CFP · 45-degree field of view
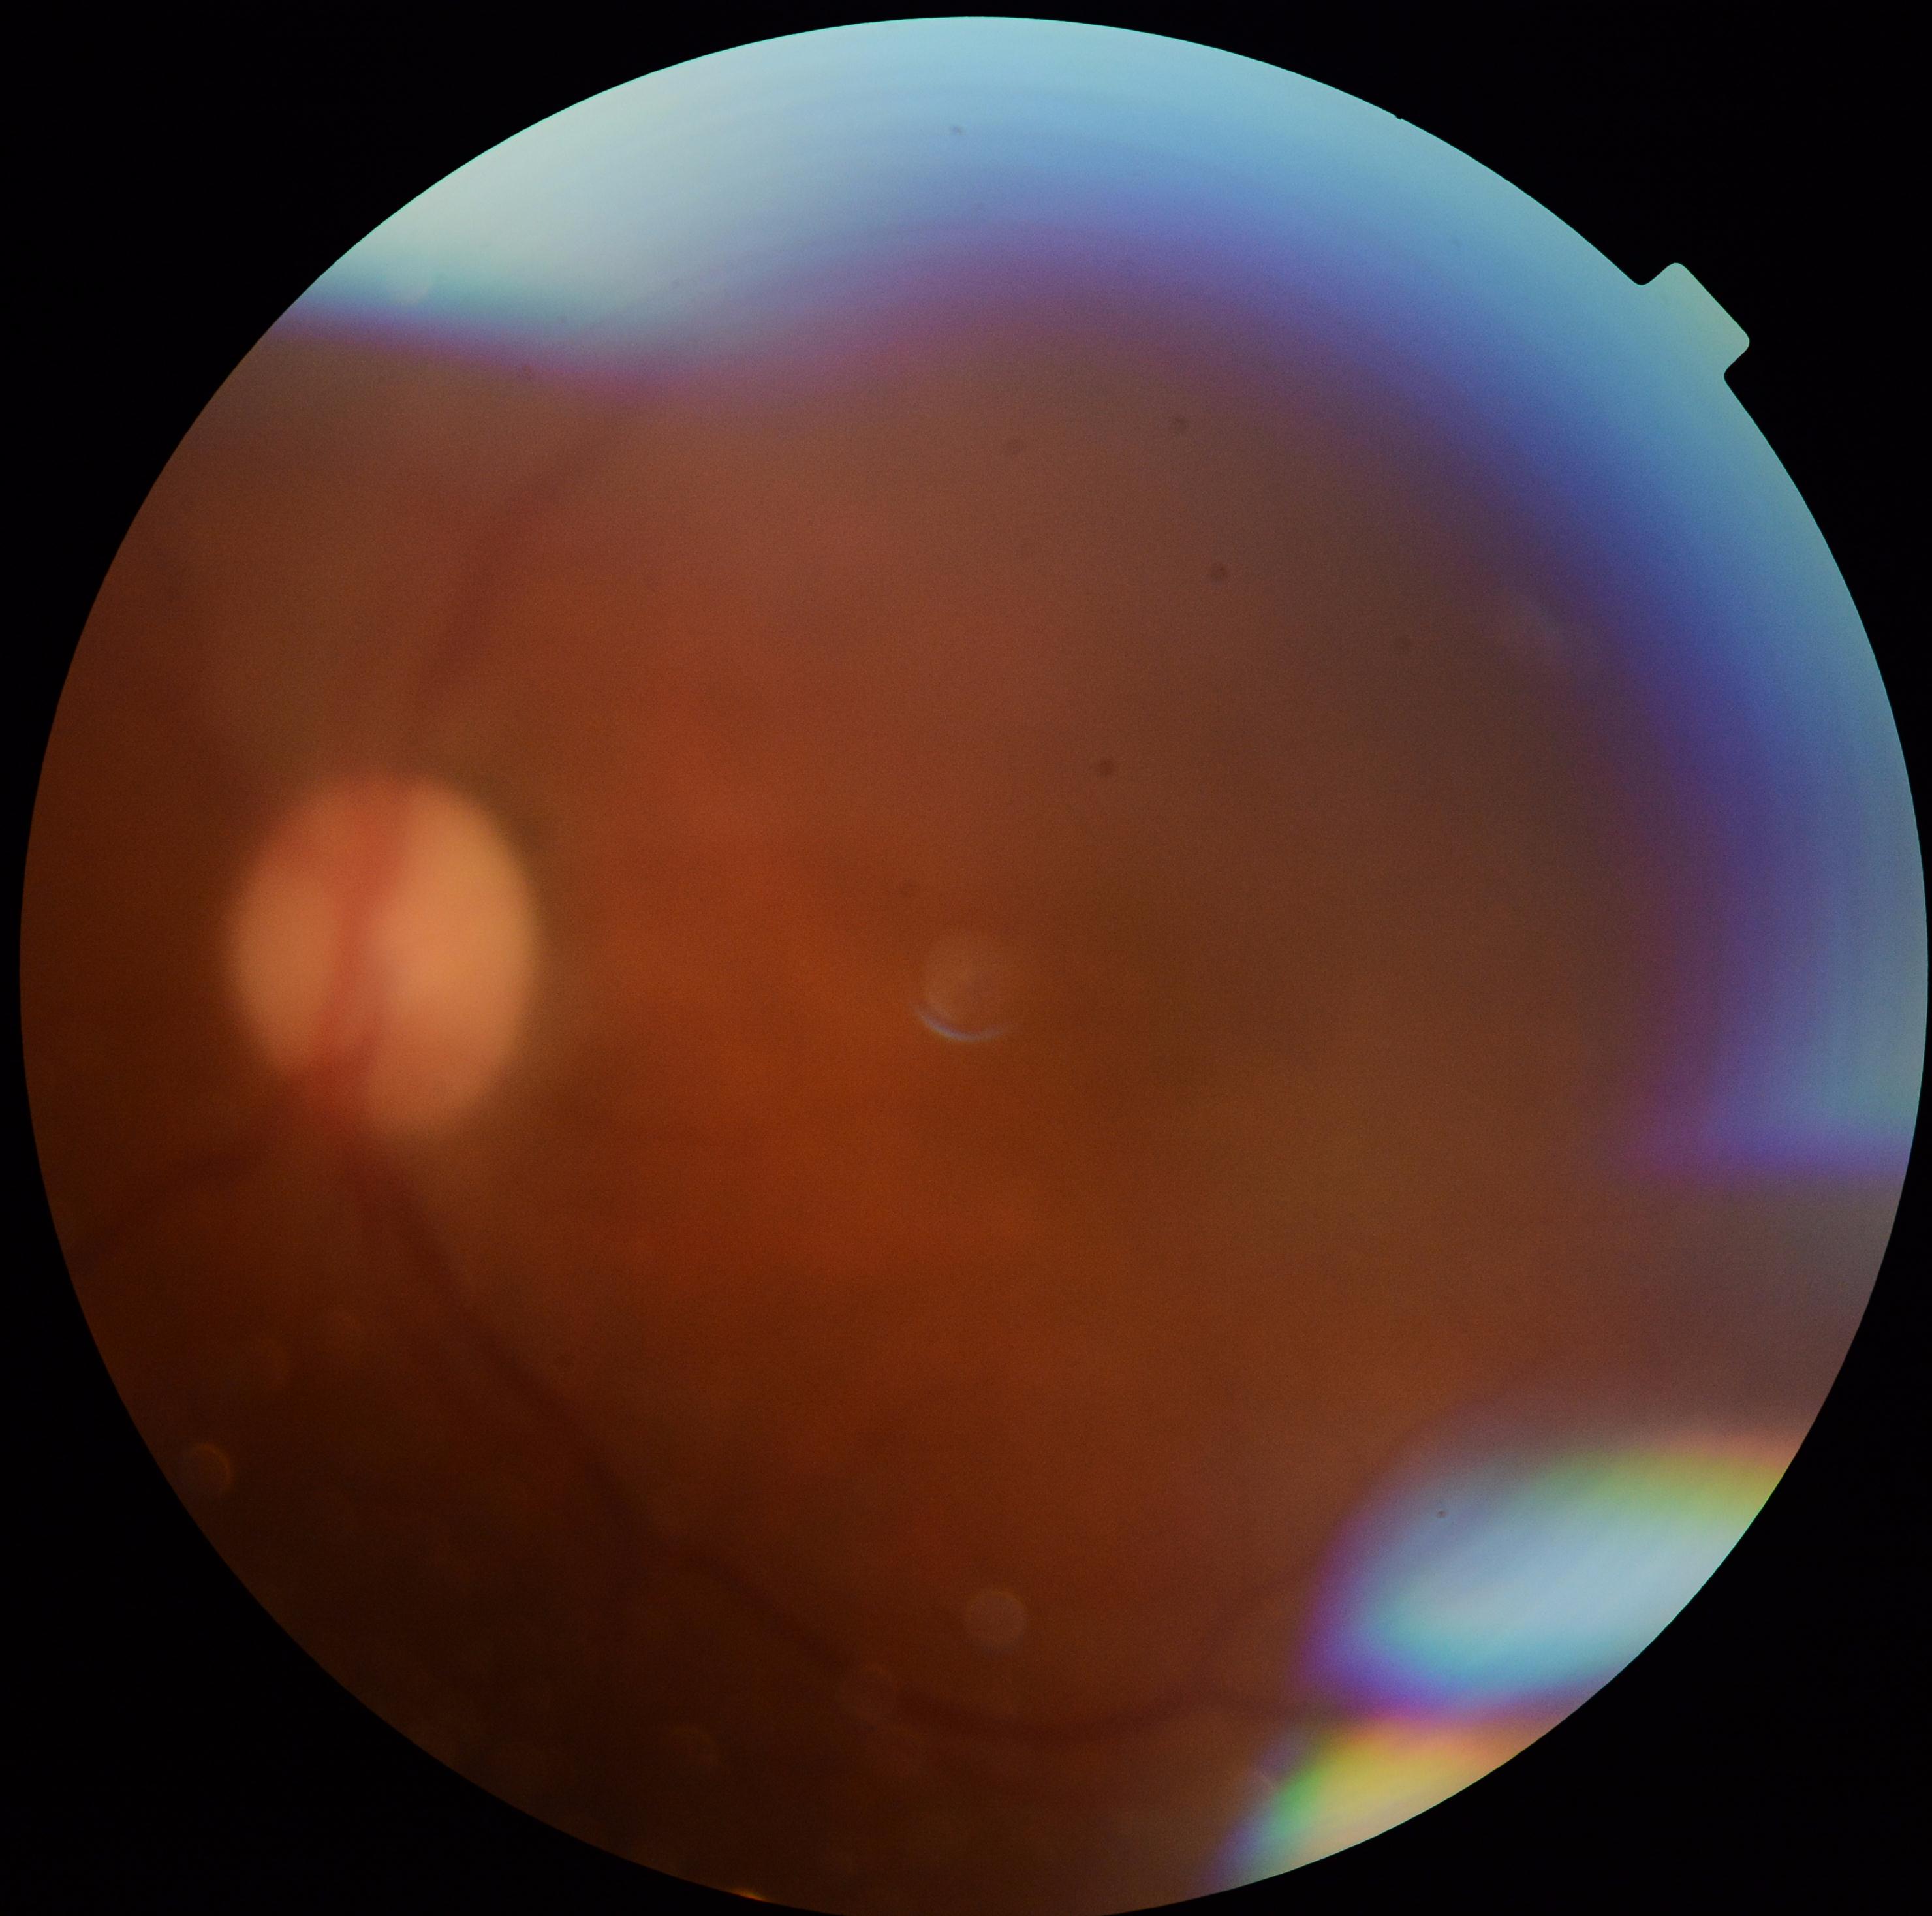 The image cannot be graded for diabetic retinopathy. Diabetic retinopathy severity: ungradable.